Wide-field fundus image from infant ROP screening. 1240x1240px:
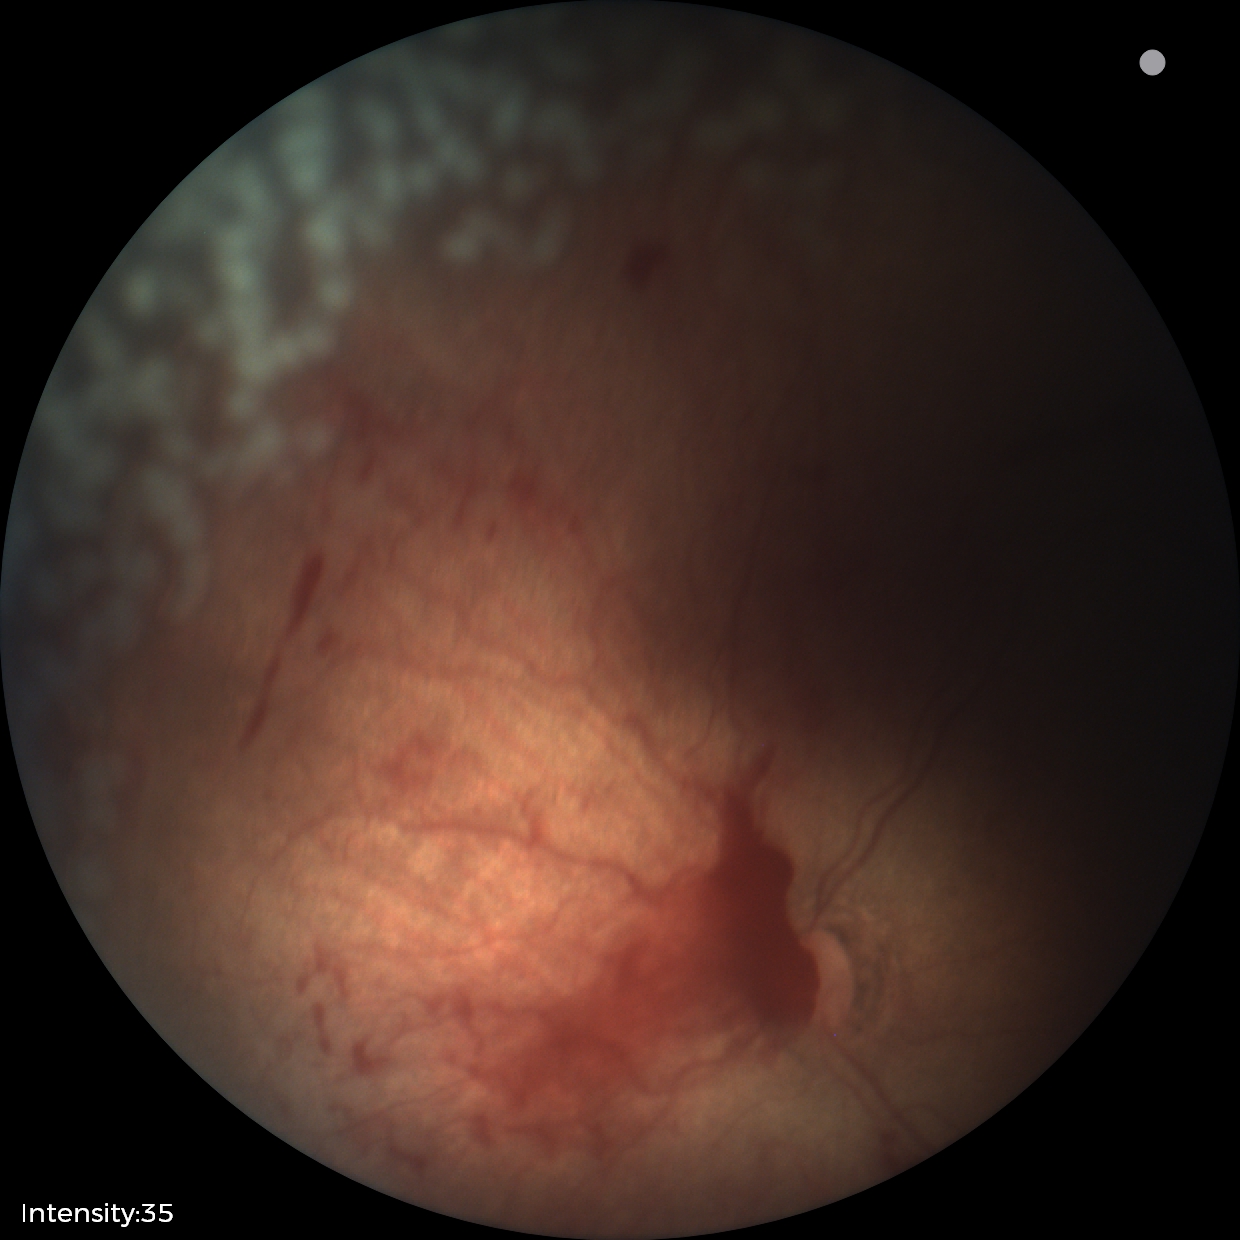 Screening: retinopathy of prematurity stage 2 | plus disease.